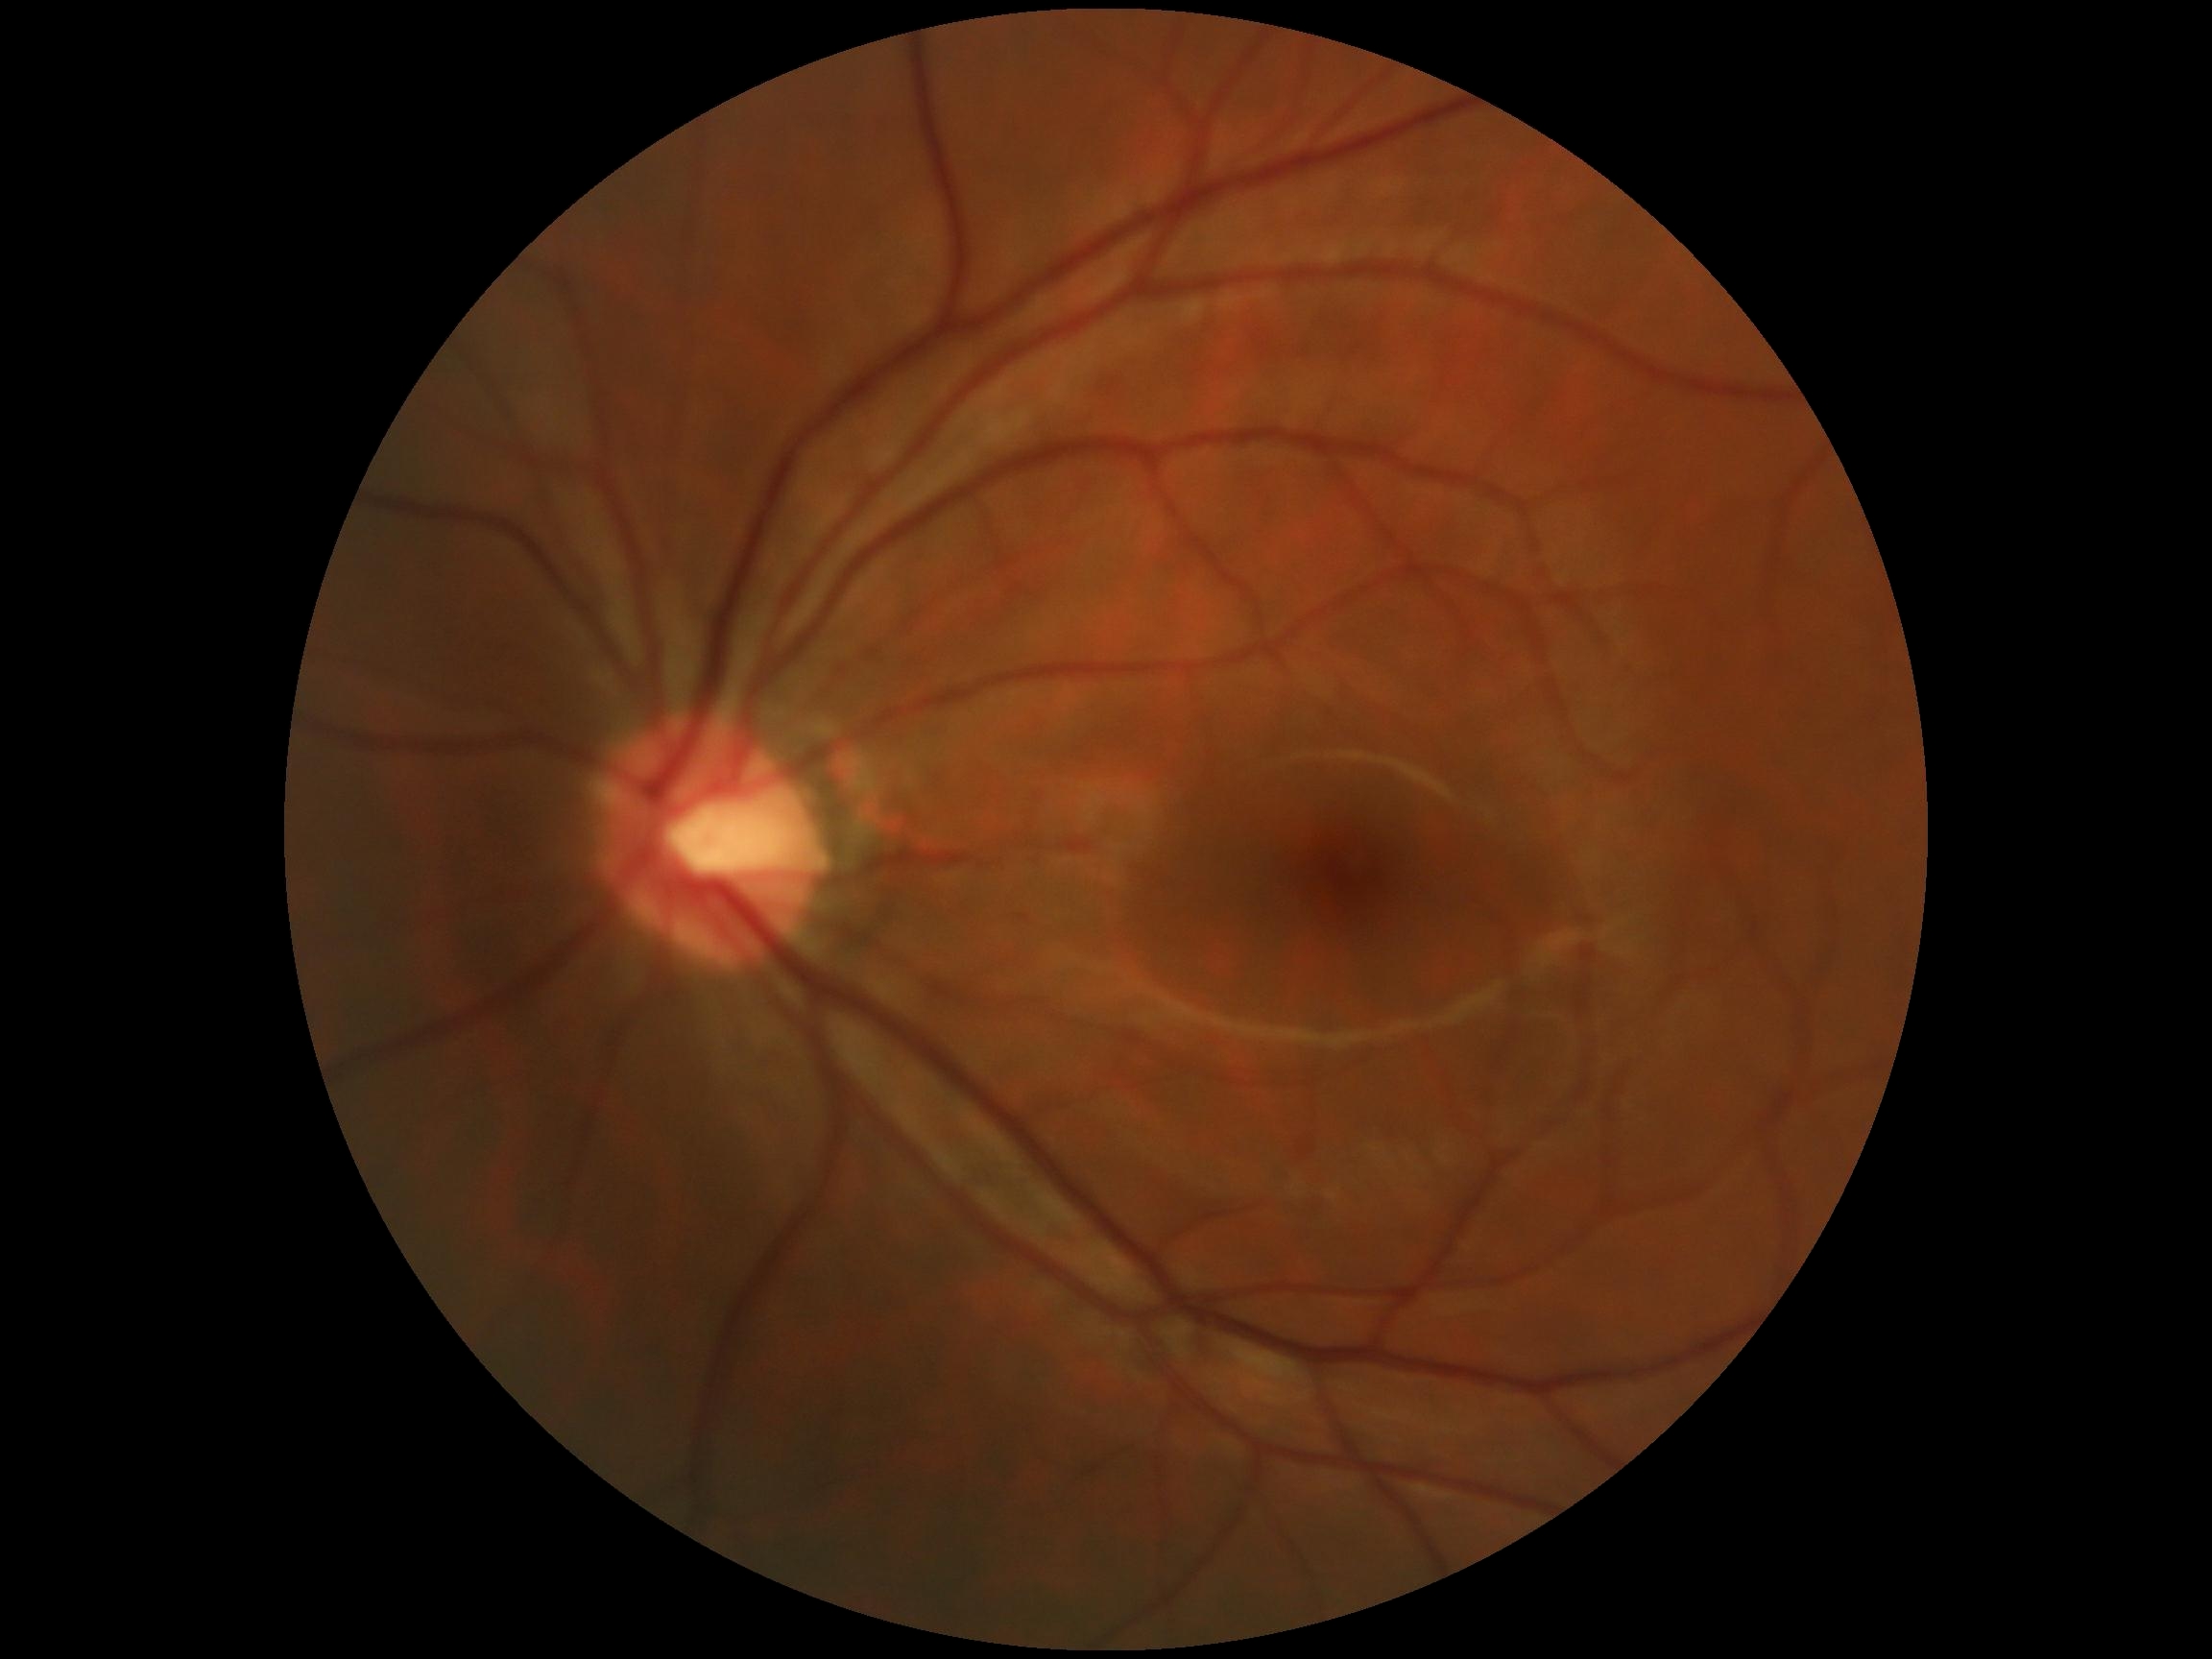
DR severity is no apparent diabetic retinopathy (grade 0).